Camera: NIDEK AFC-230:
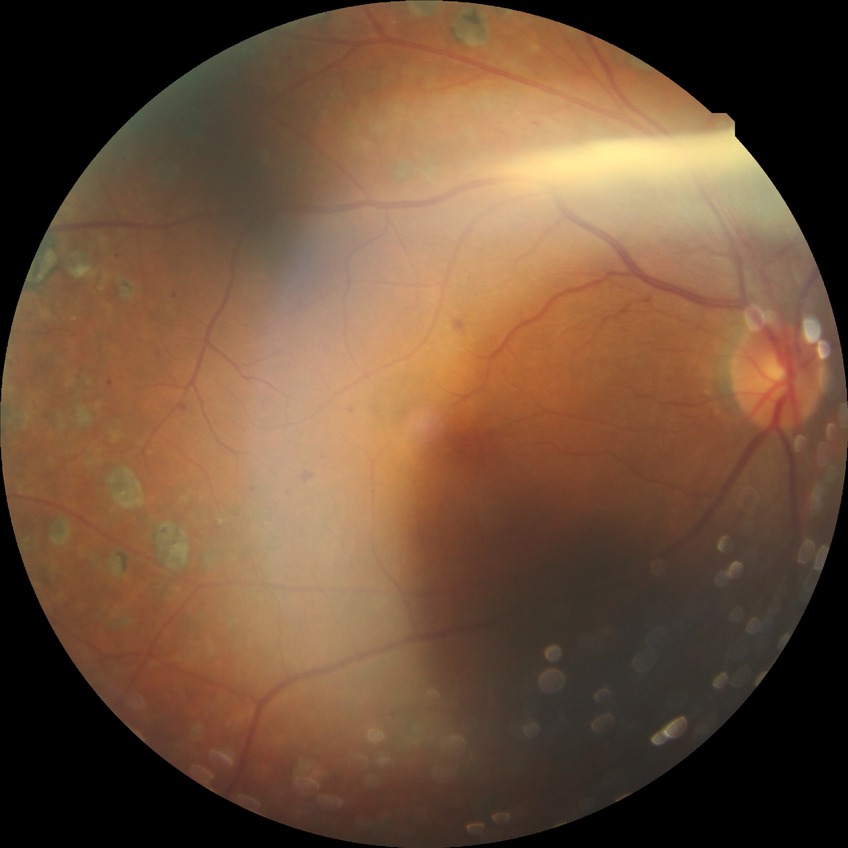

Diabetic retinopathy (DR) is PDR (proliferative diabetic retinopathy).